RetCam wide-field infant fundus image; captured with the Clarity RetCam 3 (130° field of view)
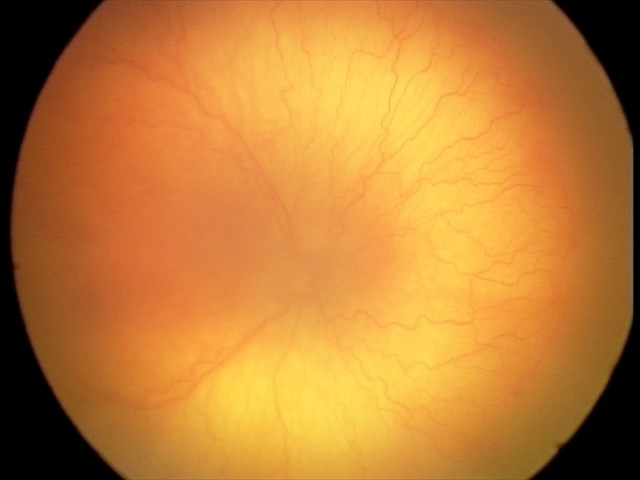 Plus disease present.
Screening series with aggressive retinopathy of prematurity.